Retinal fundus photograph — 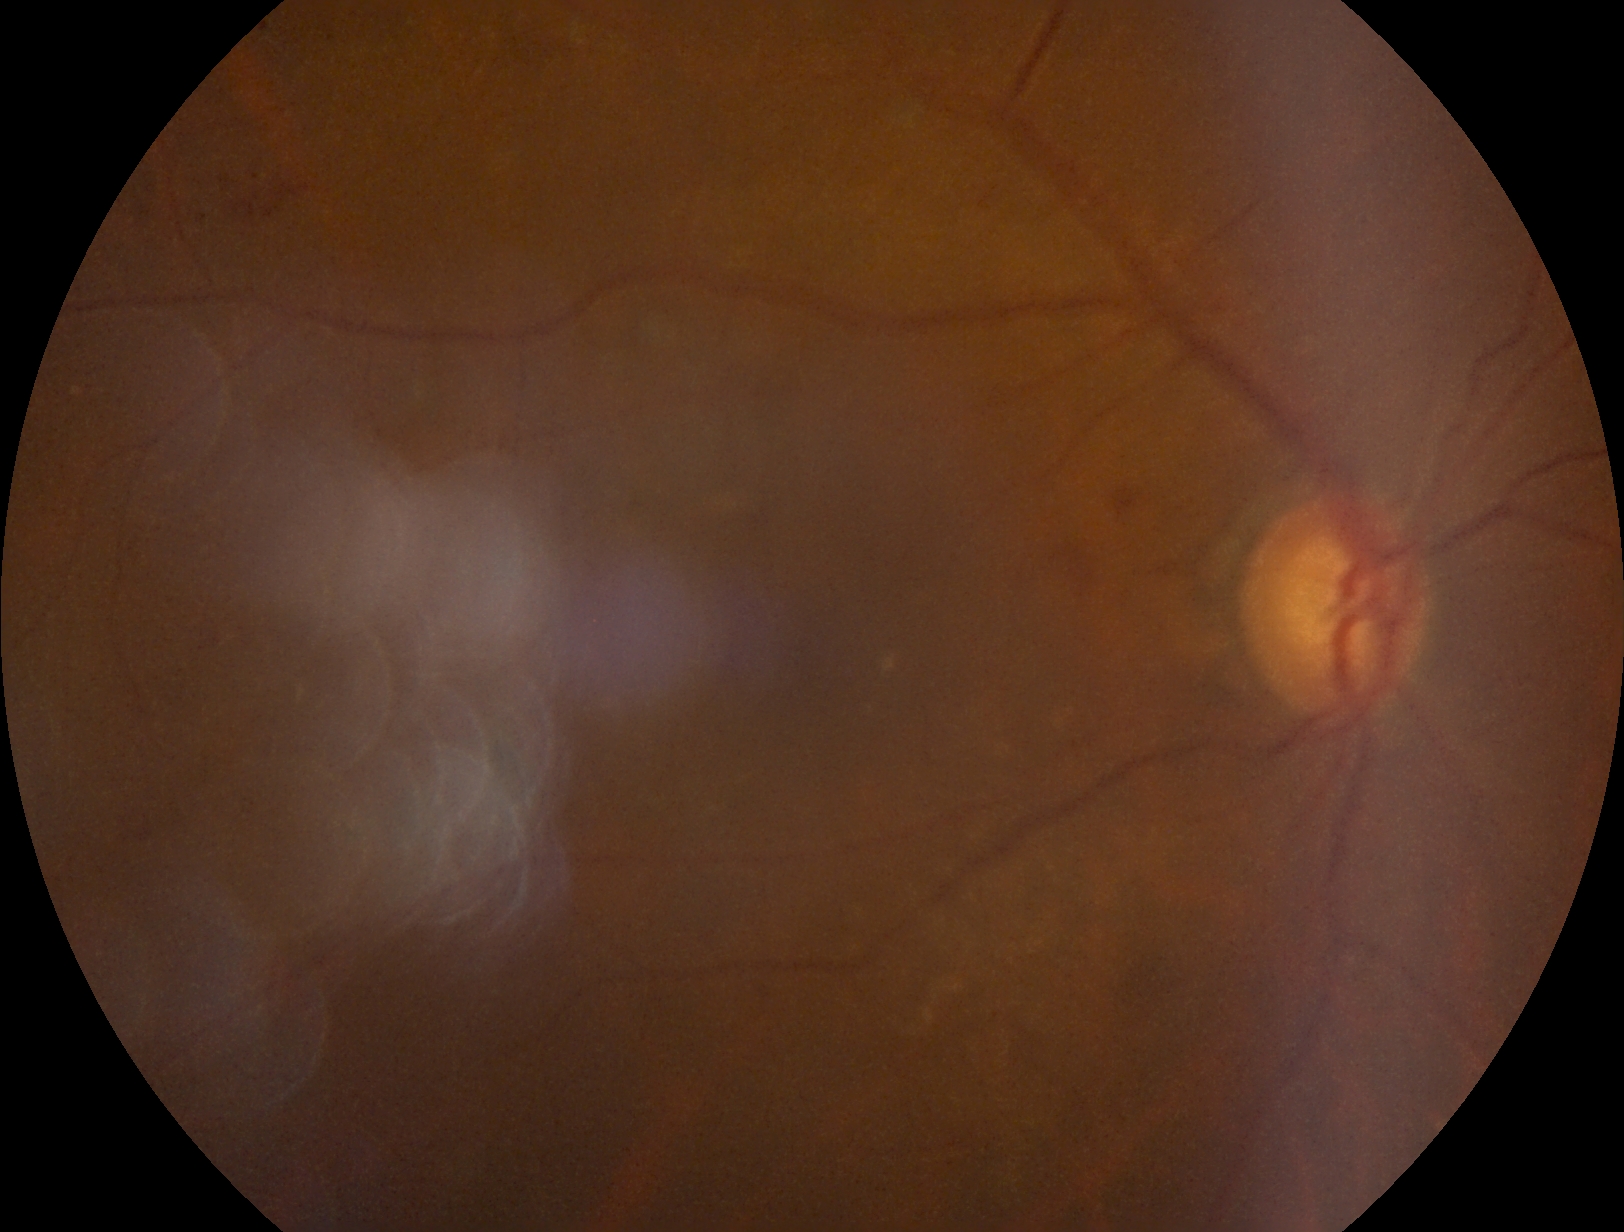 Diabetic retinopathy severity: moderate NPDR (grade 2).